NIDEK AFC-230:
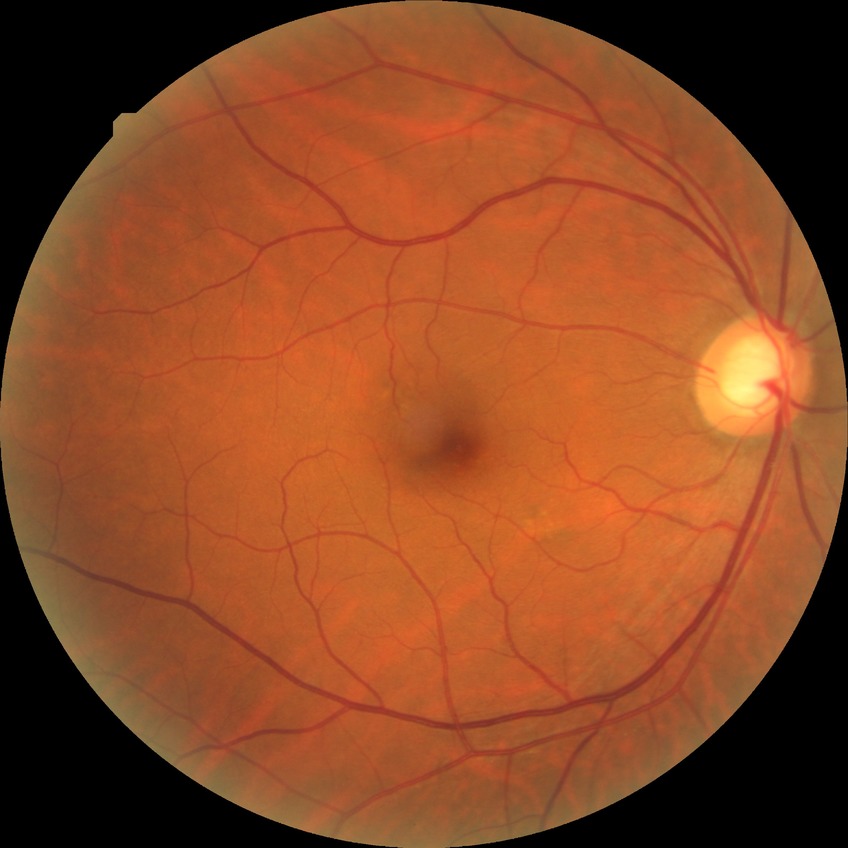
Diabetic retinopathy (DR) is no diabetic retinopathy (NDR).